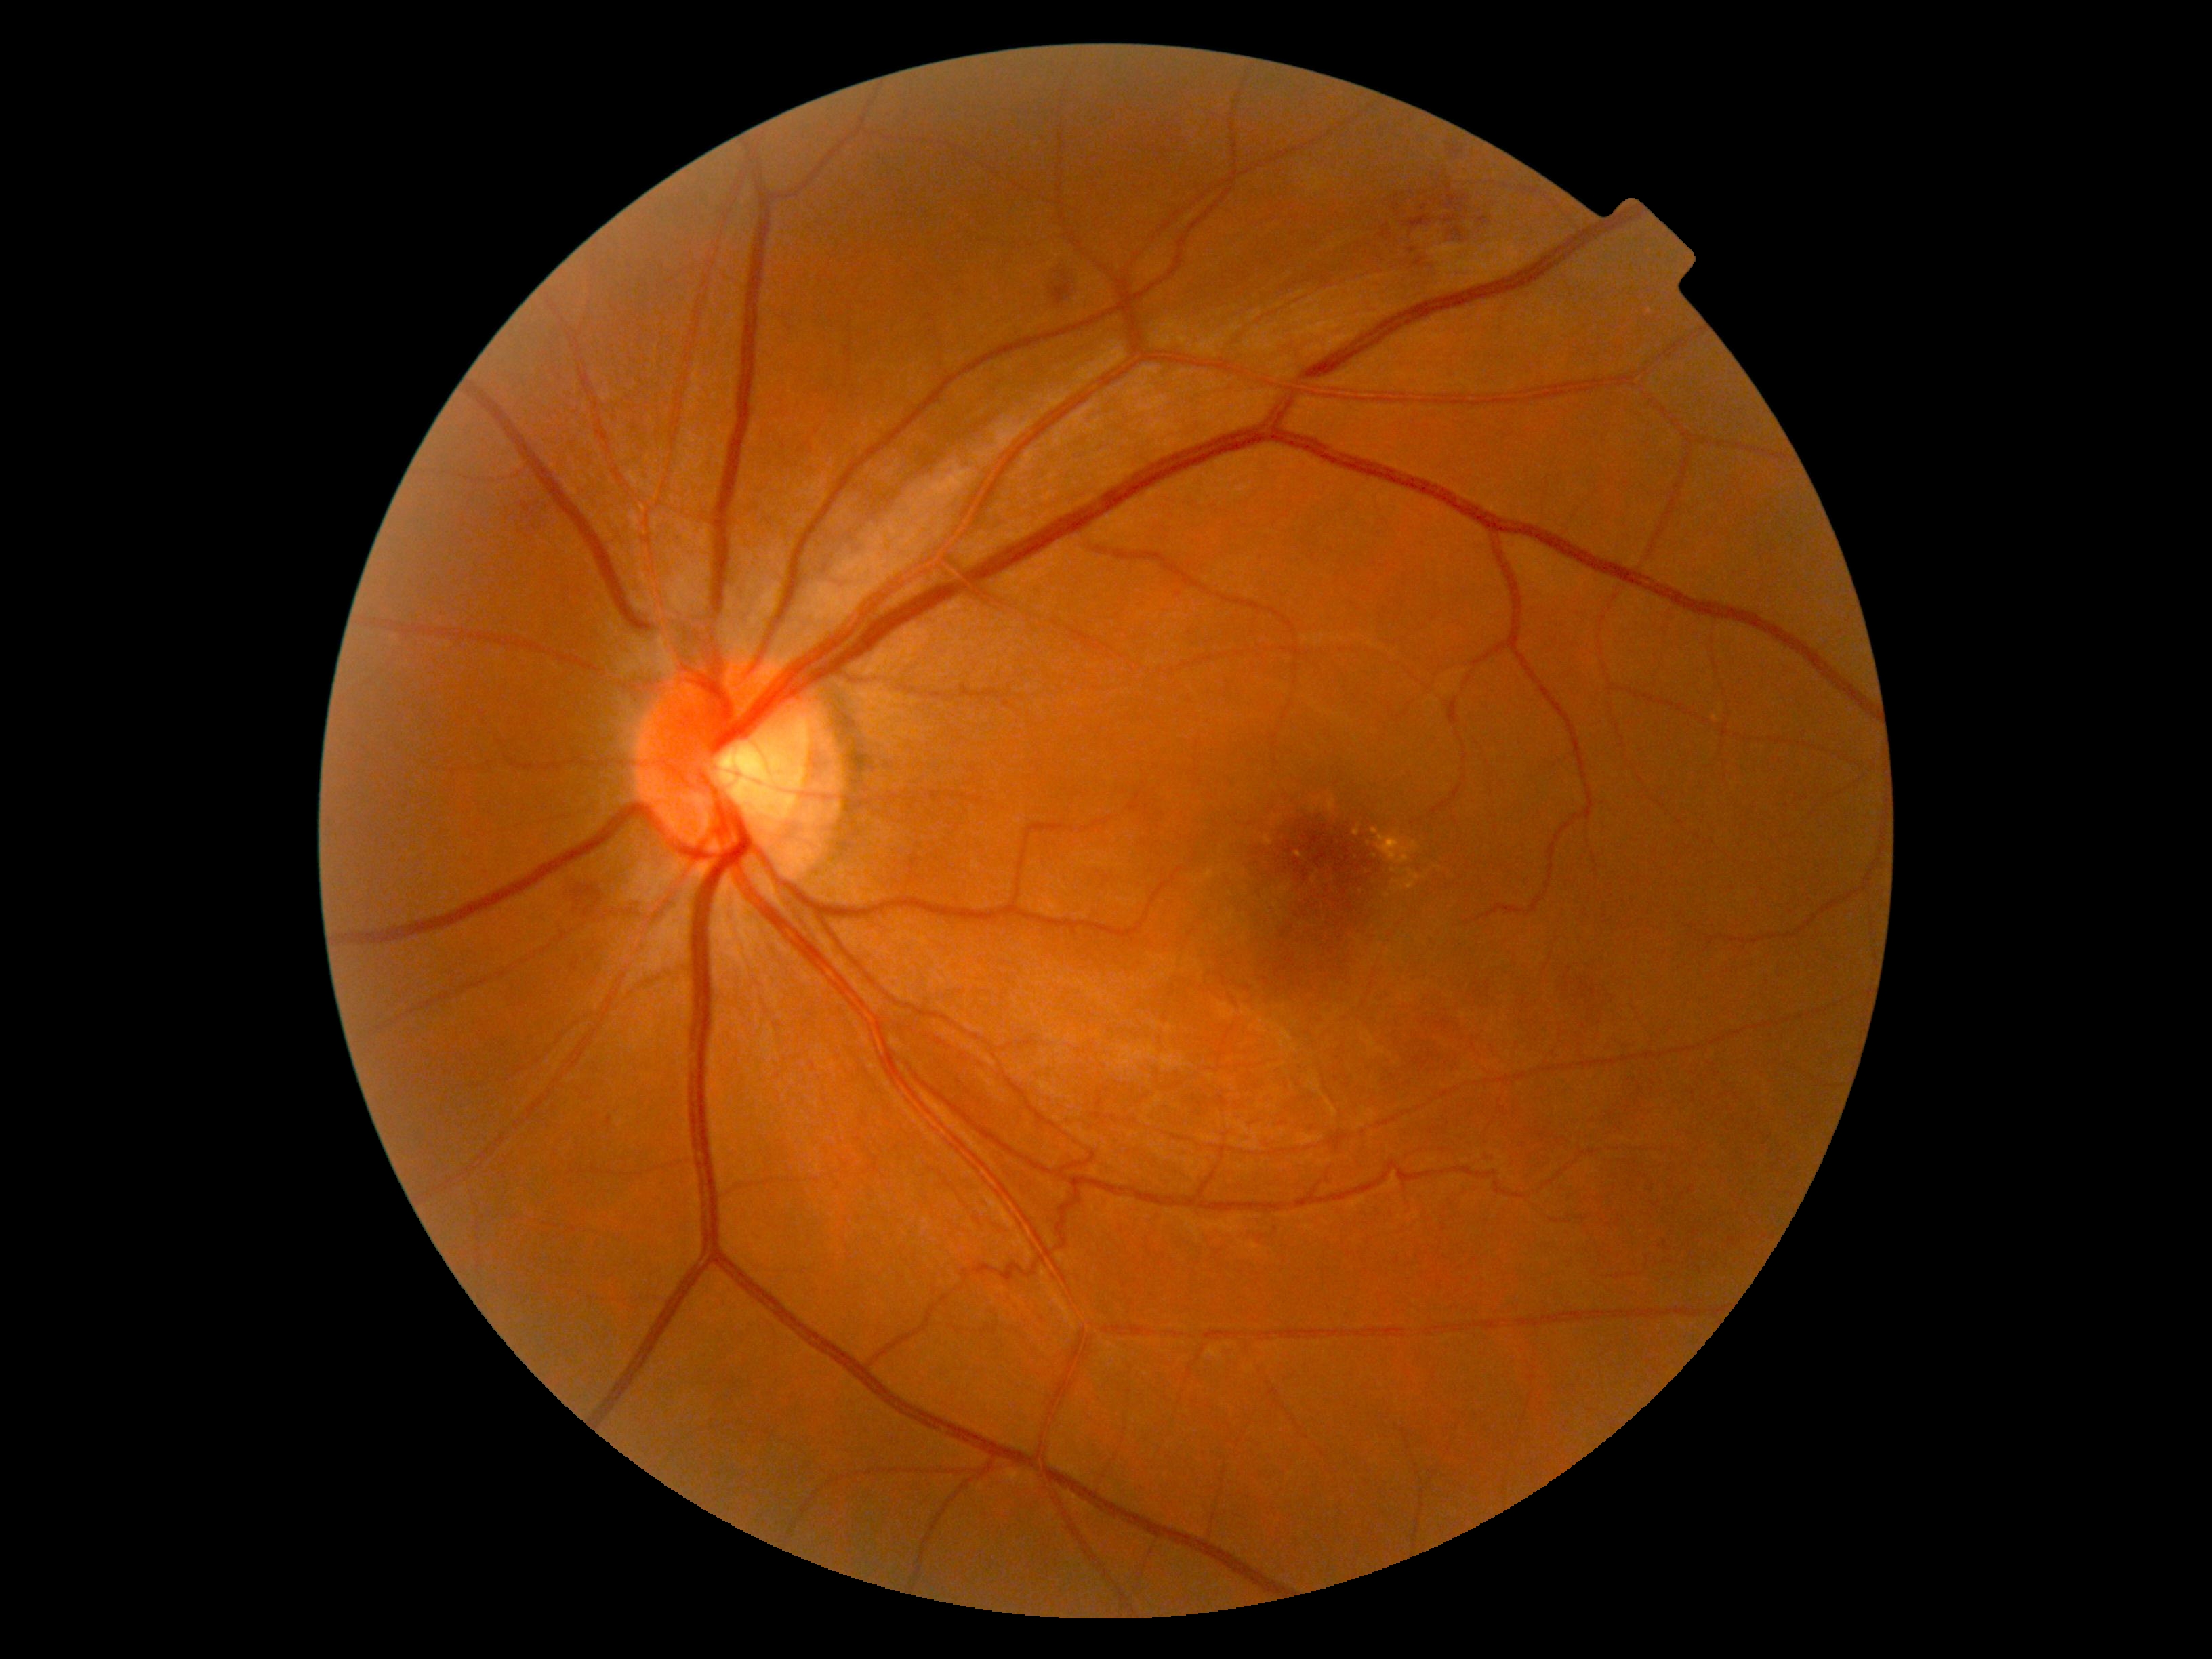

{"dr_grade": "2/4"}